Wide-field fundus photograph of an infant; camera: Clarity RetCam 3 (130° FOV) — 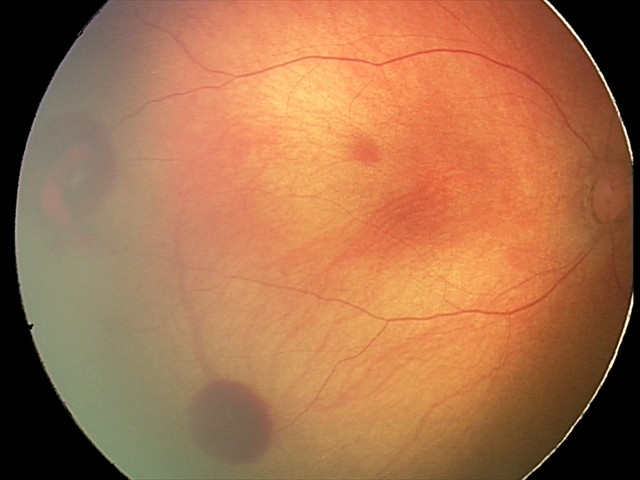 Series diagnosed as retinal hemorrhages.